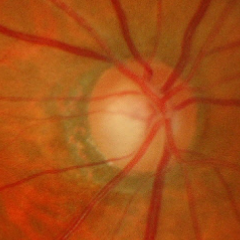

Q: Does this eye have glaucoma?
A: Advanced glaucoma.